2352x1568
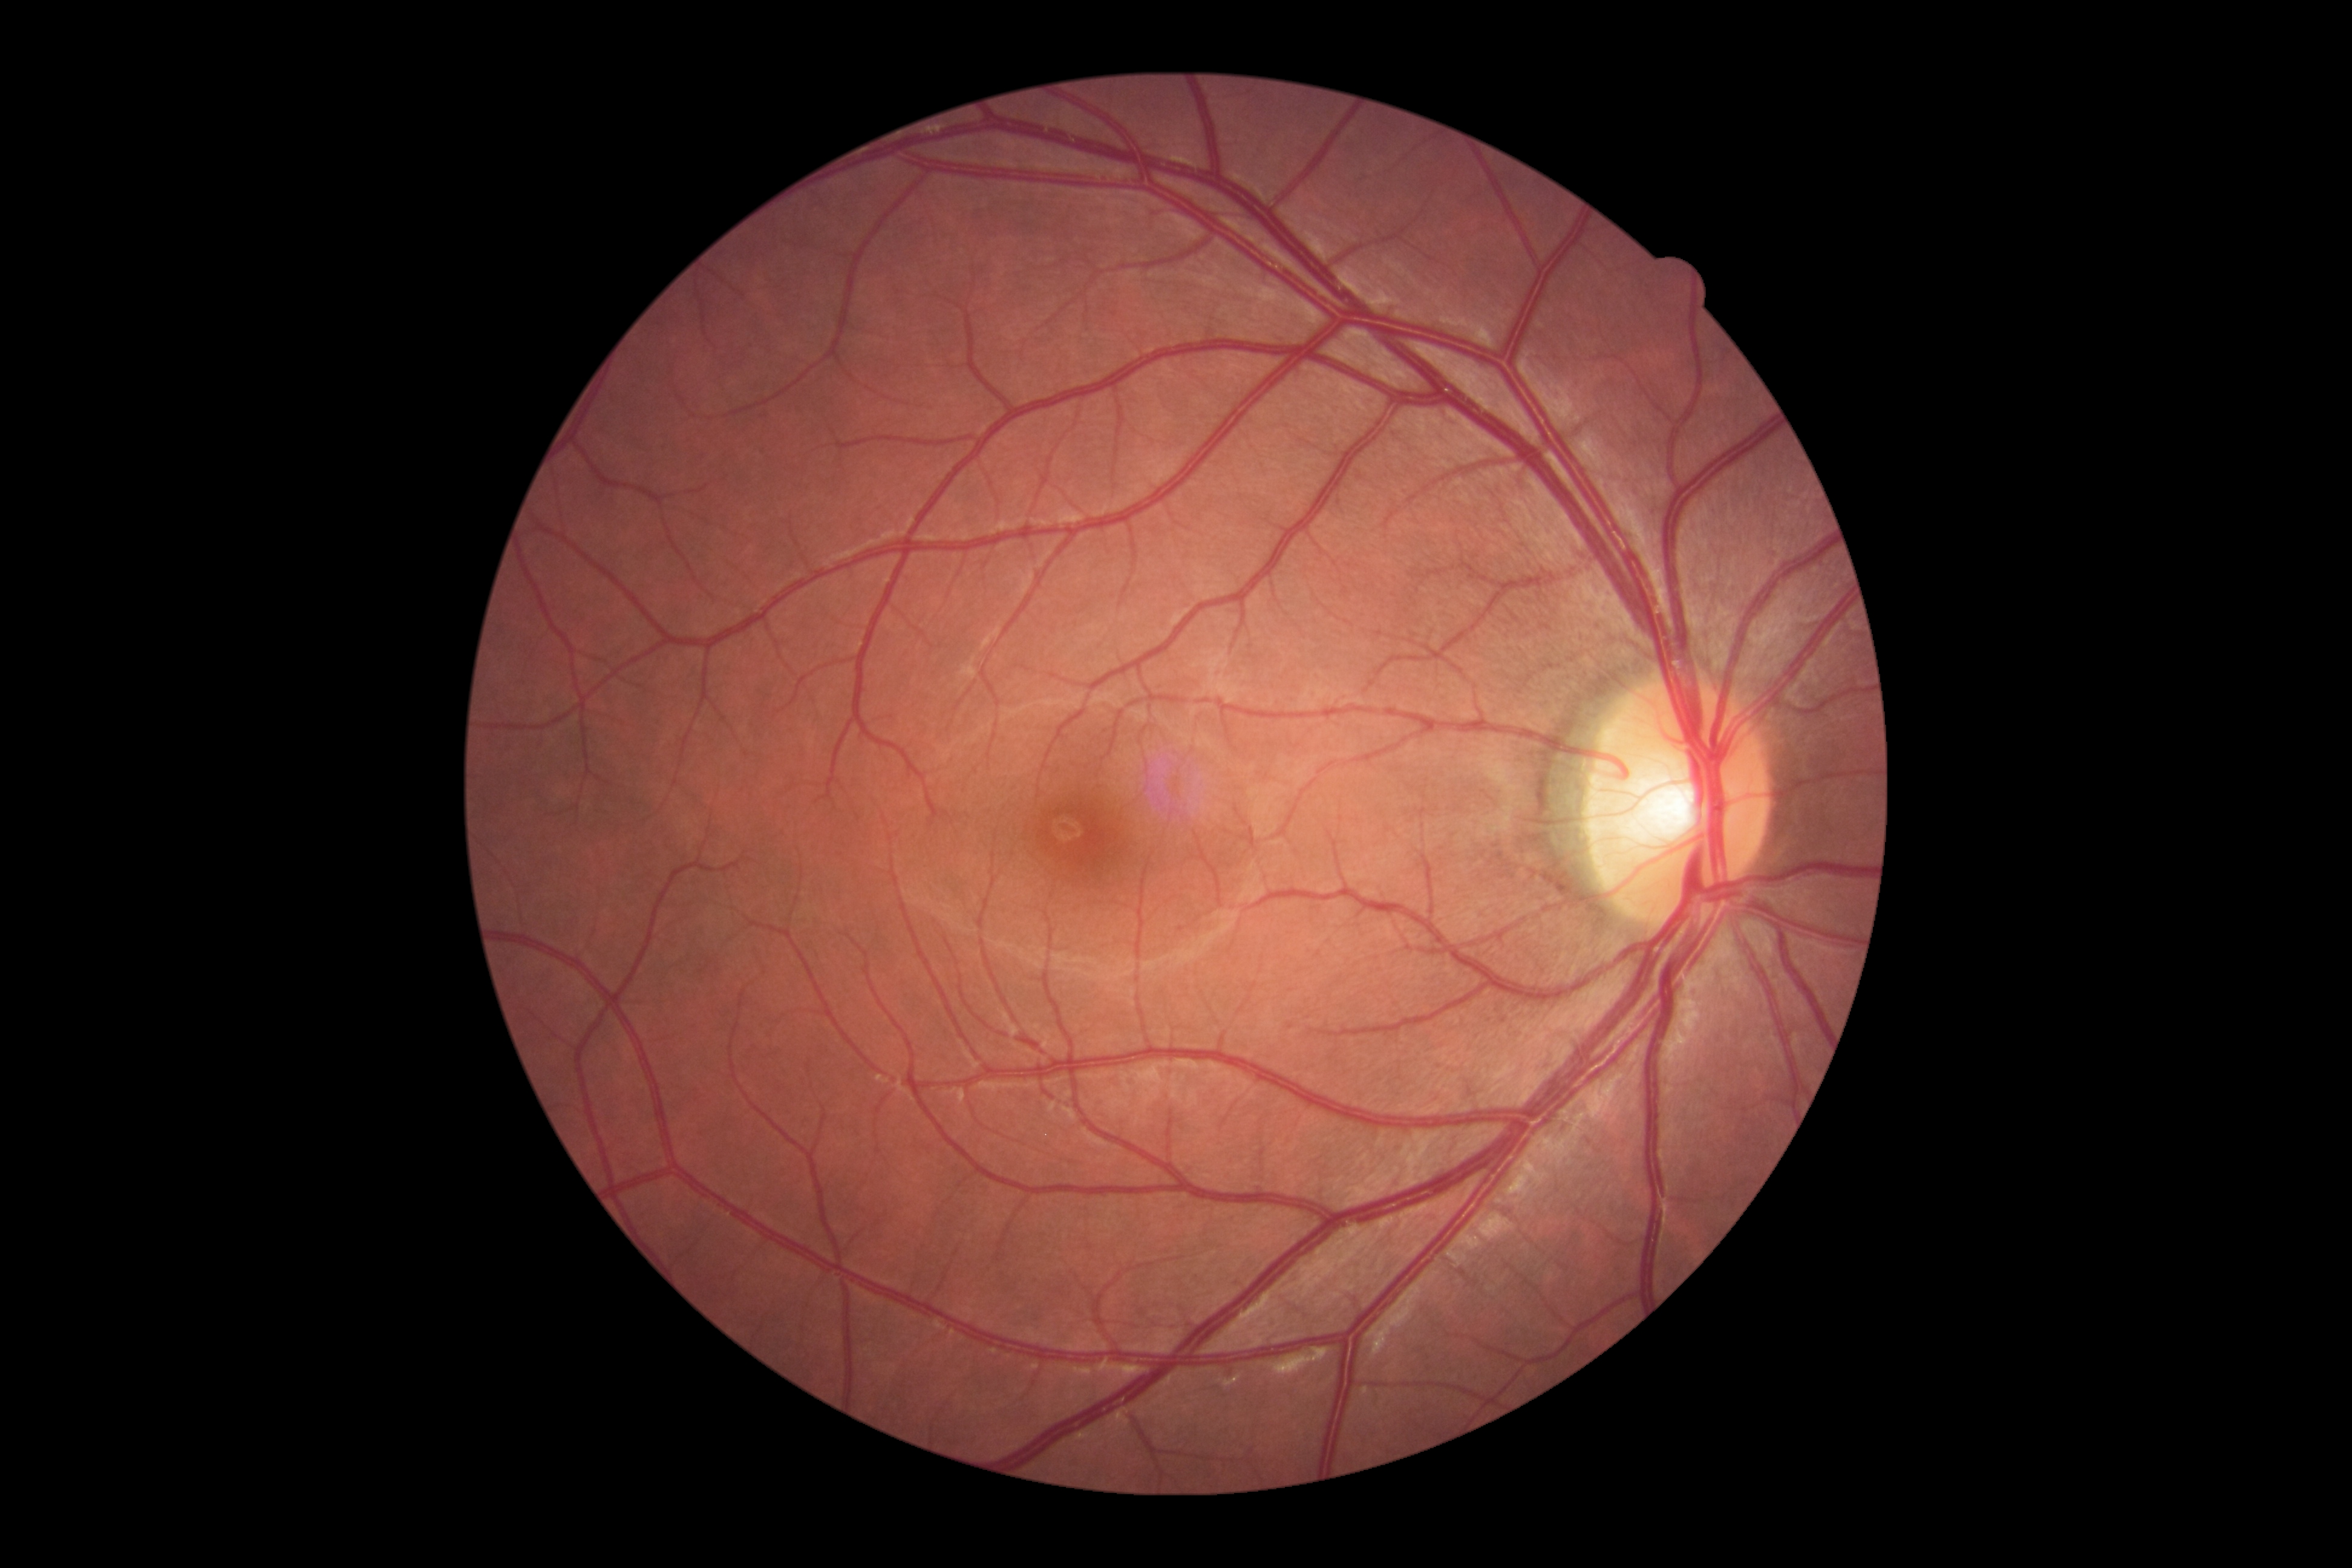 Annotations:
– DR severity: grade 0 (no apparent retinopathy)